Wide-field contact fundus photograph of an infant; 1240x1240px.
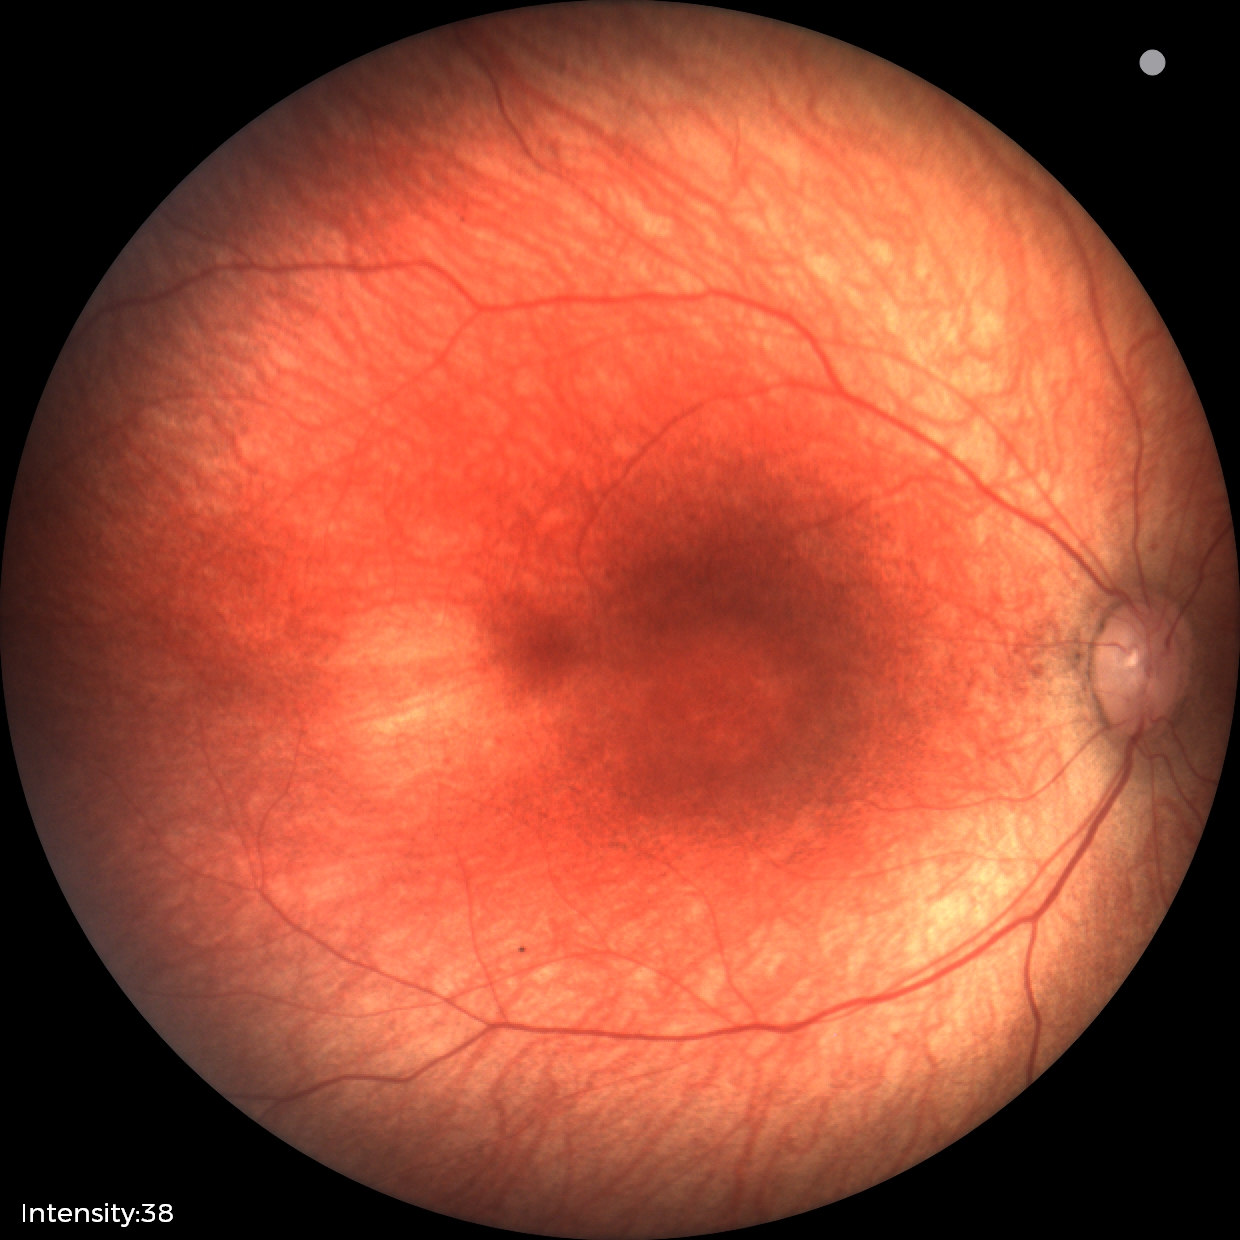 Assessment: normal retinal appearance.